Non-mydriatic — 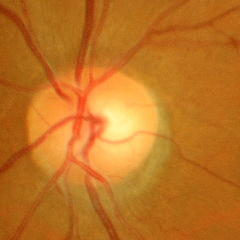
Optic disc photograph demonstrating no glaucoma.